Fundus photo:
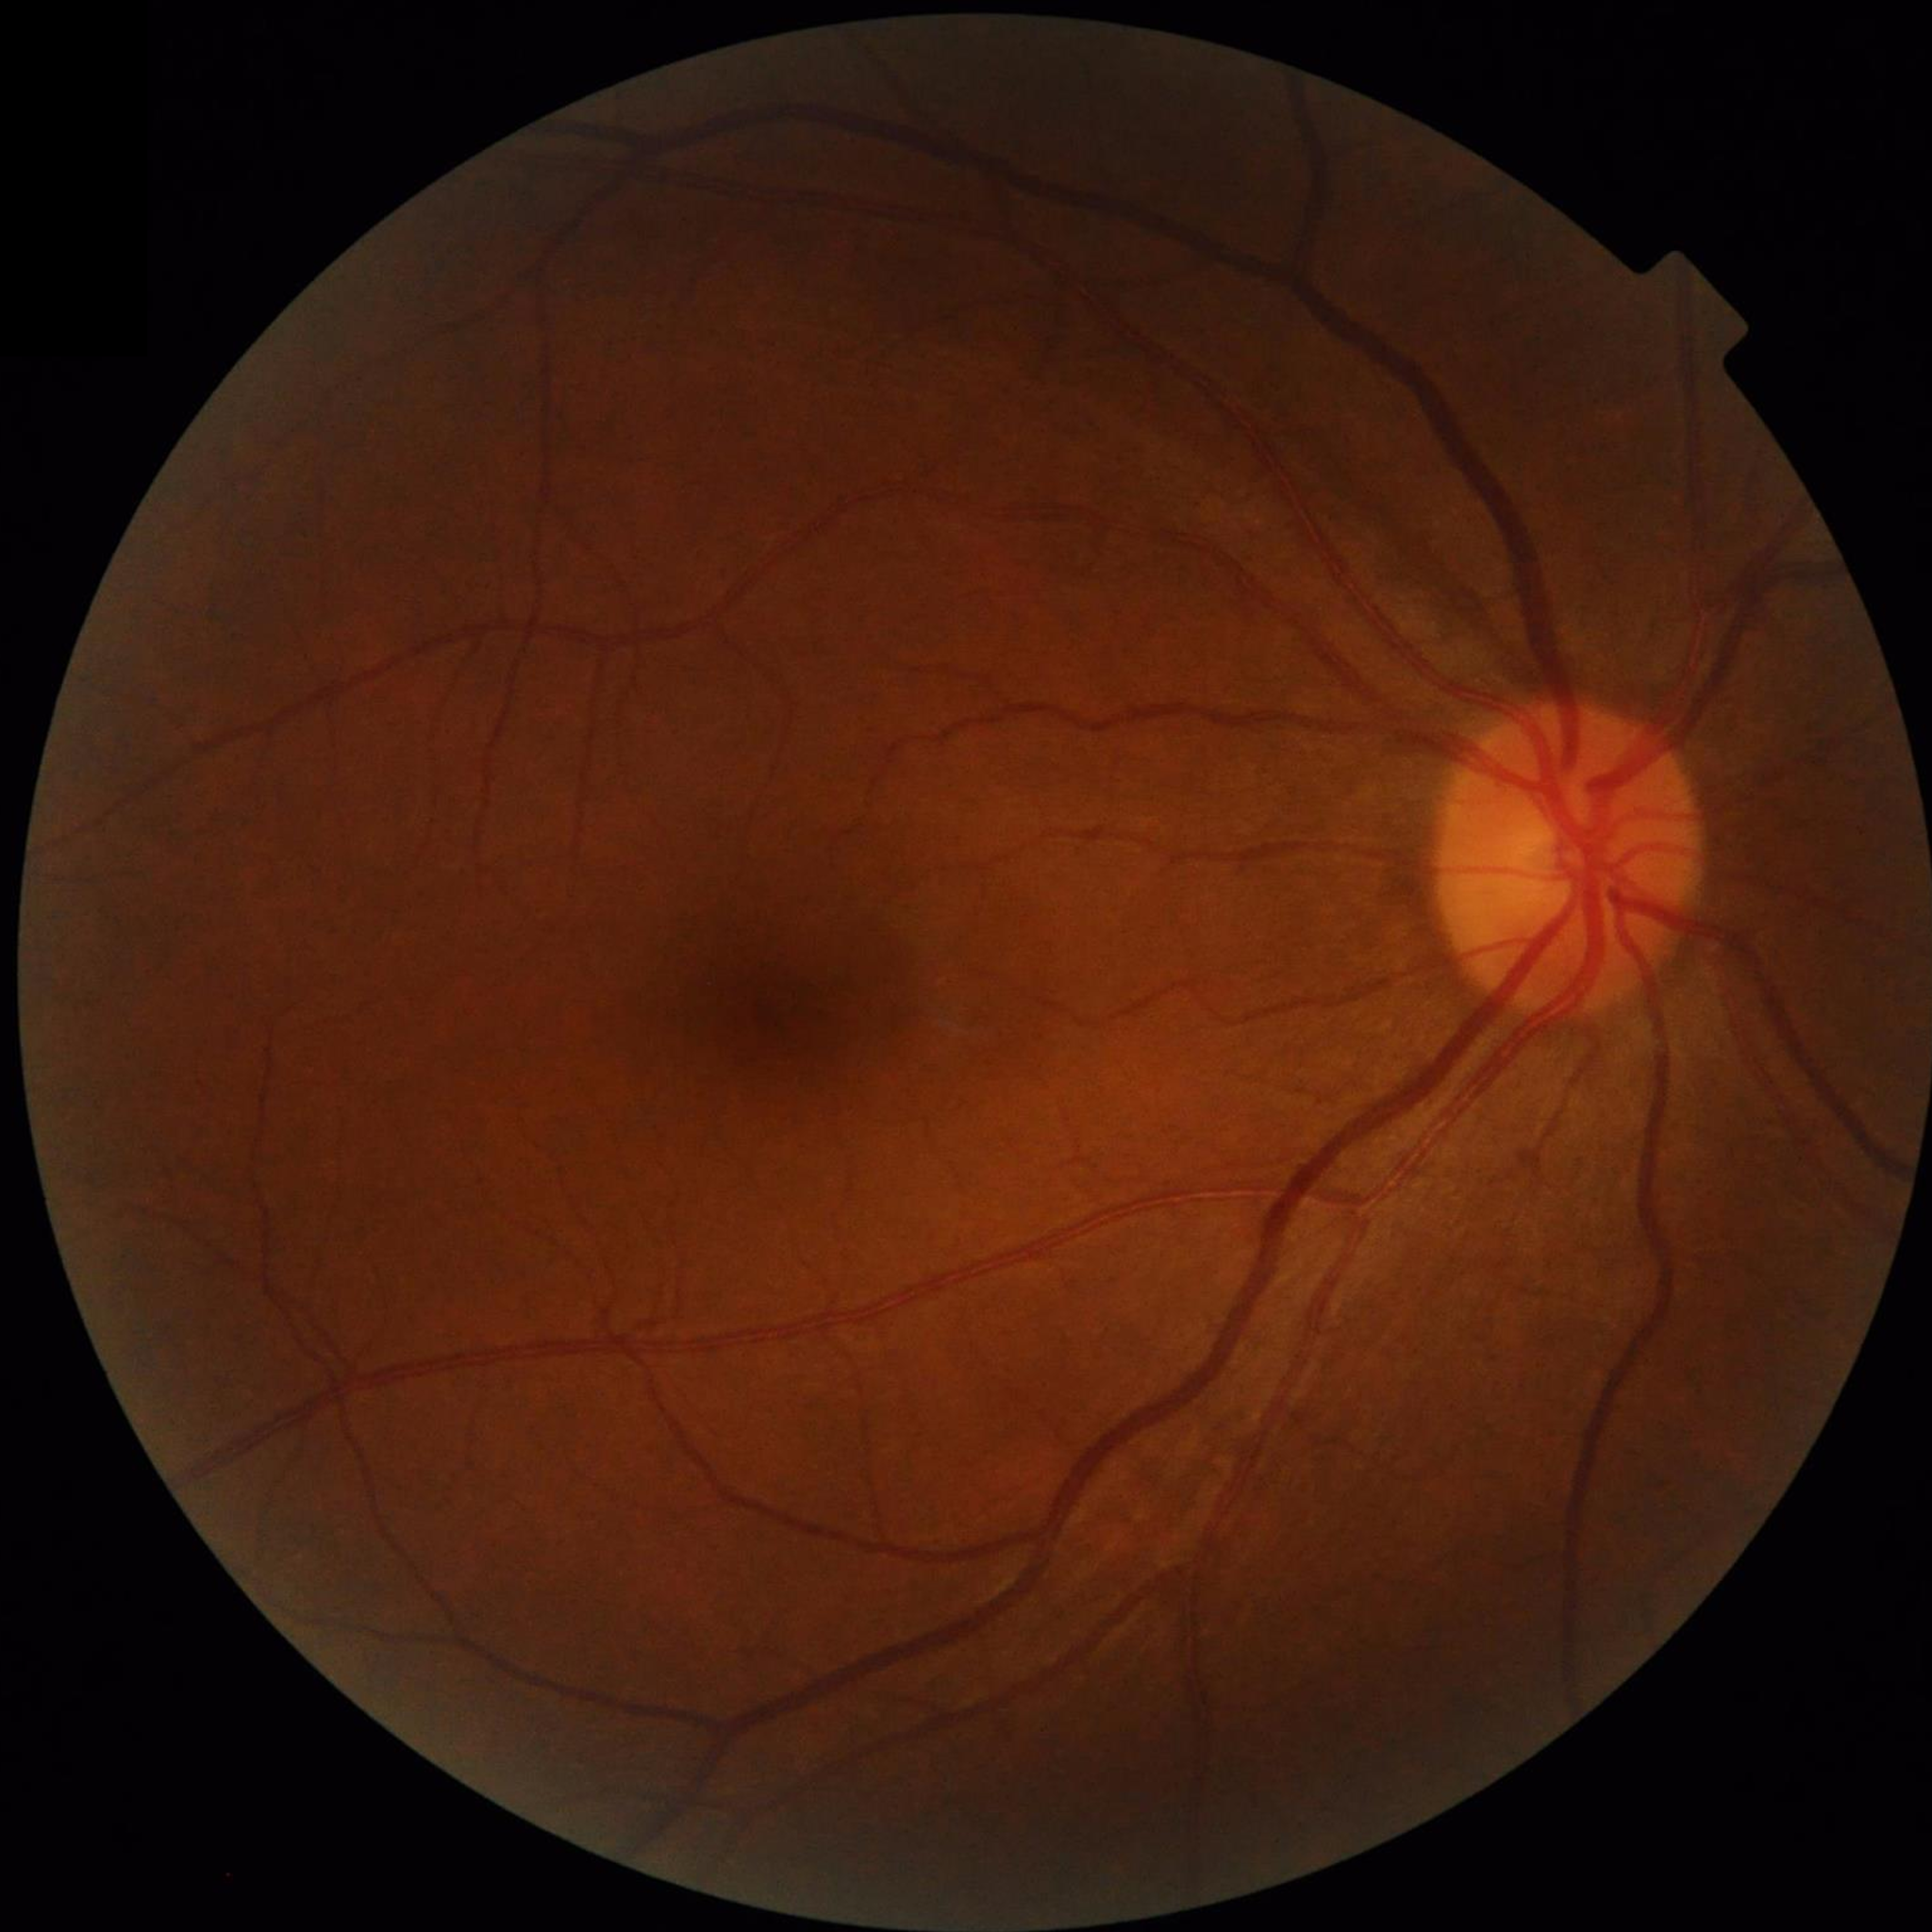 Clinical diagnosis: no AMD, DR, or glaucomatous findings; Quality assessment: adequate.